Fundus photo, image size 2352x1568.
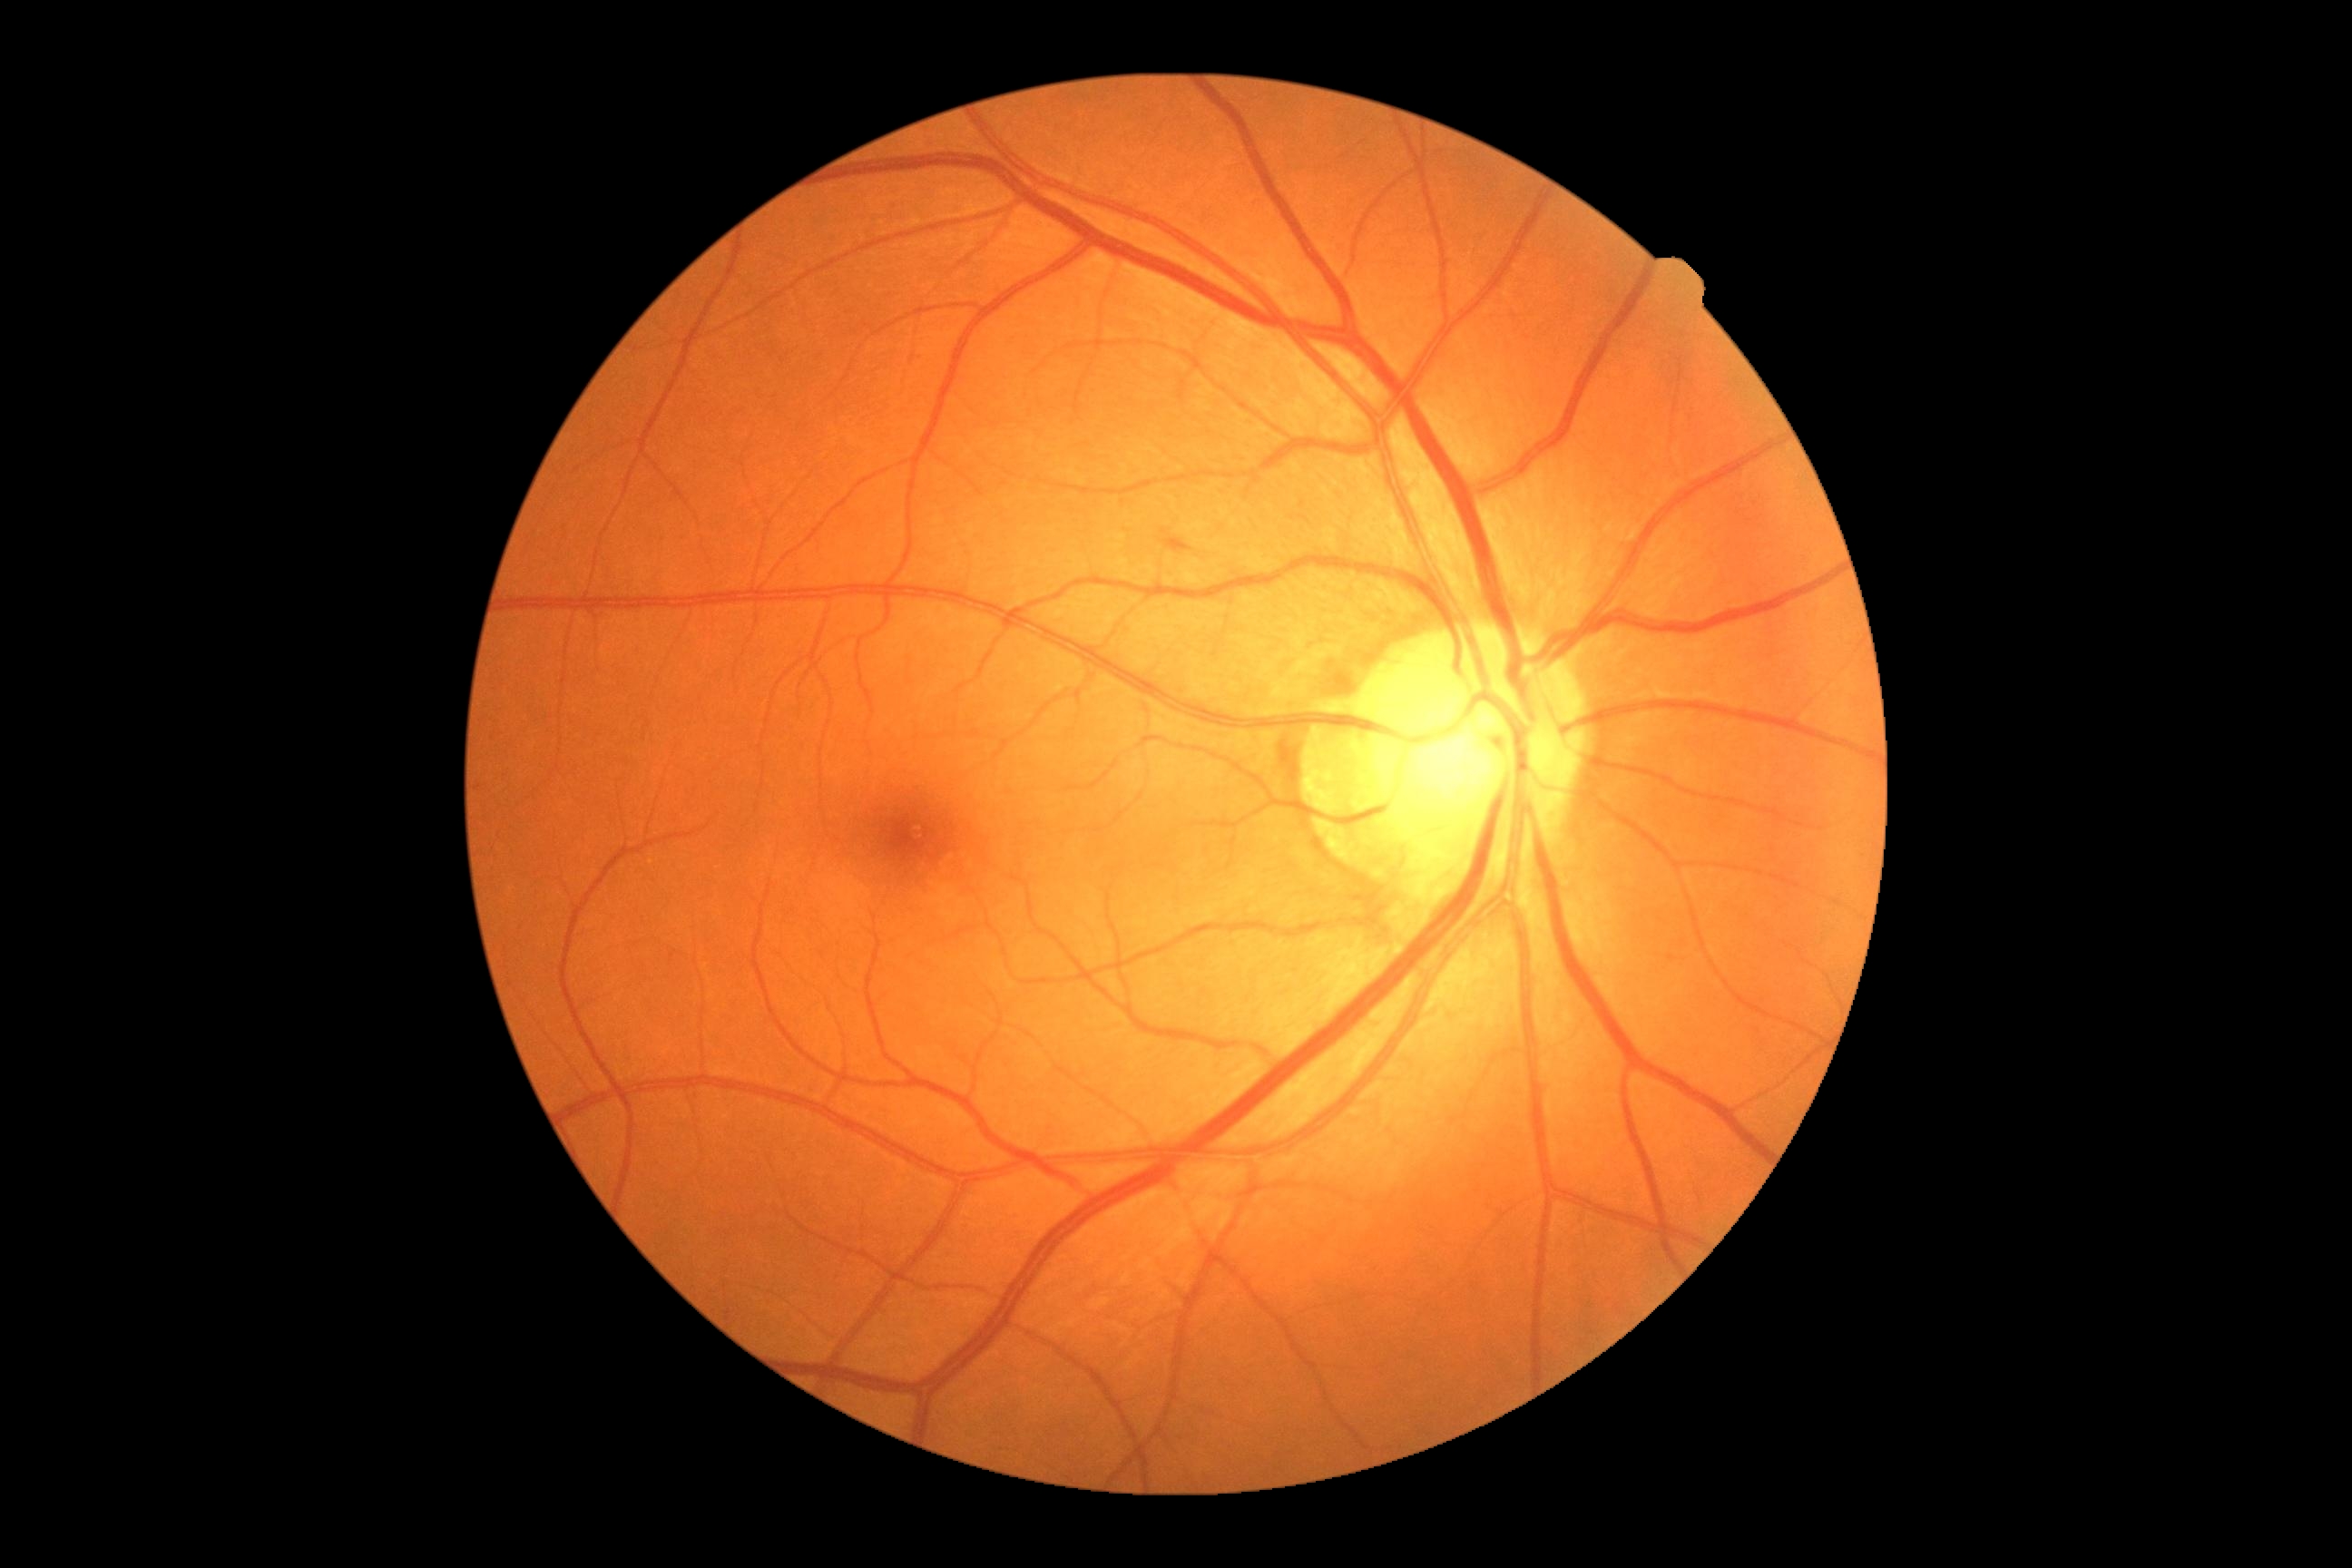

Diabetic retinopathy (DR): grade 2 (moderate NPDR).